45° field of view · image size 848x848: 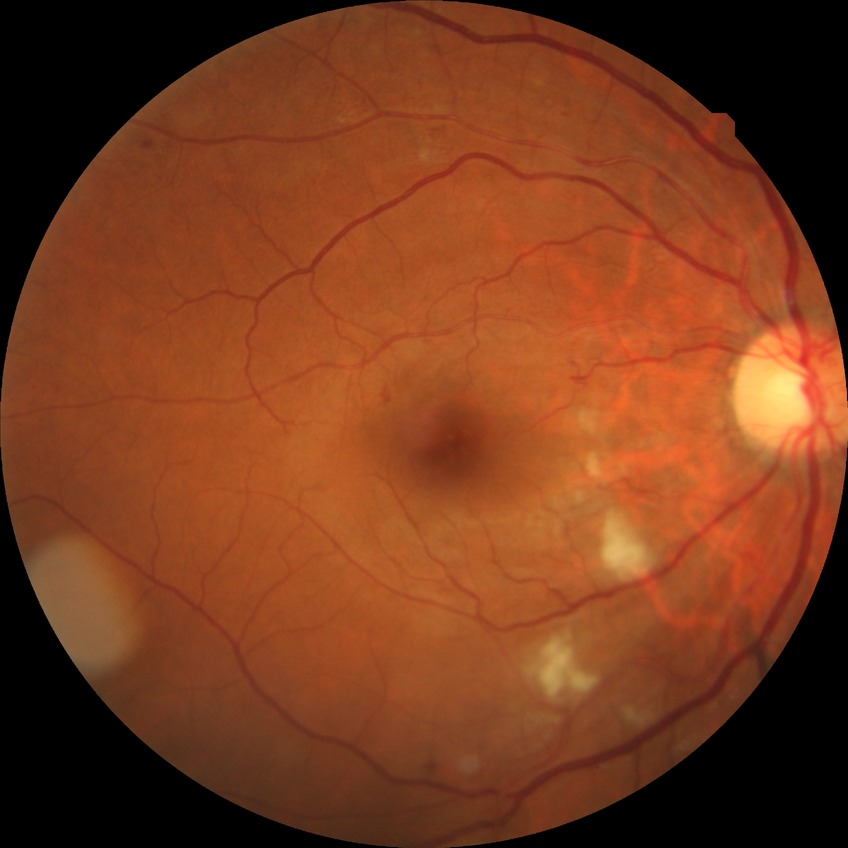

Modified Davis grading is pre-proliferative diabetic retinopathy.